1932 by 1910 pixels; FOV: 45 degrees
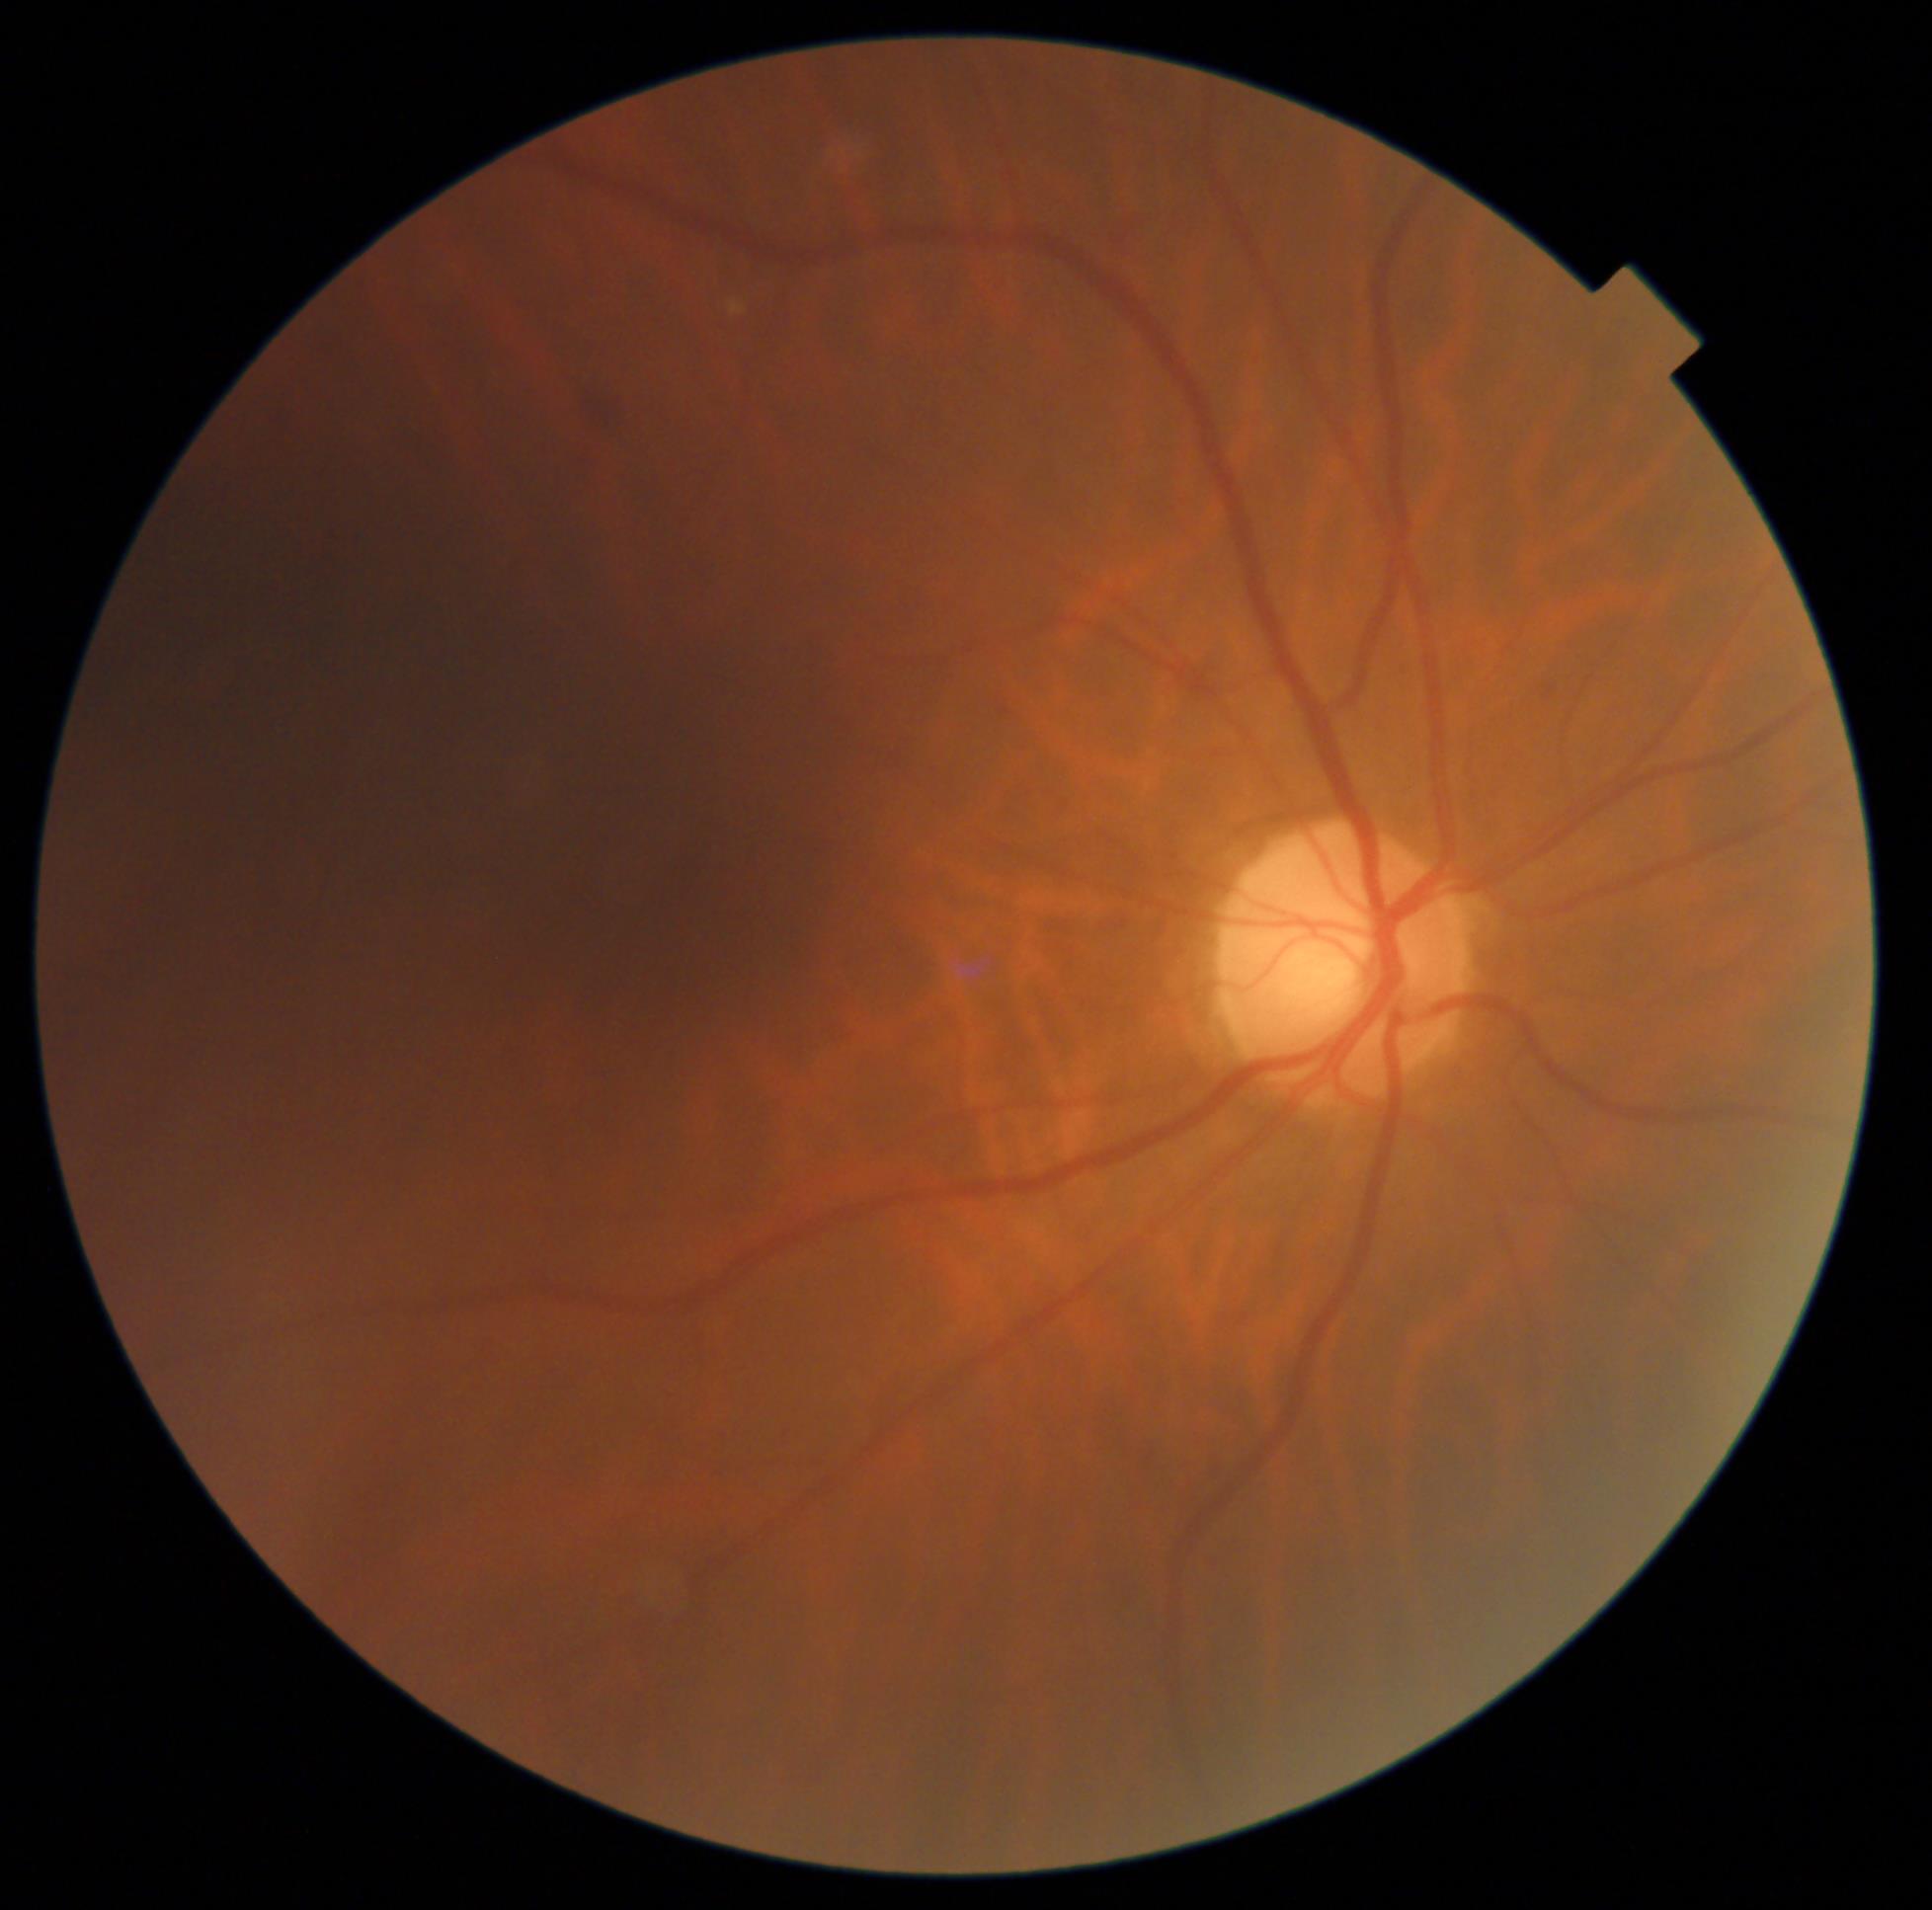 DR class@non-proliferative diabetic retinopathy; DR severity@grade 2.